45-degree field of view, NIDEK AFC-230, 848x848px: 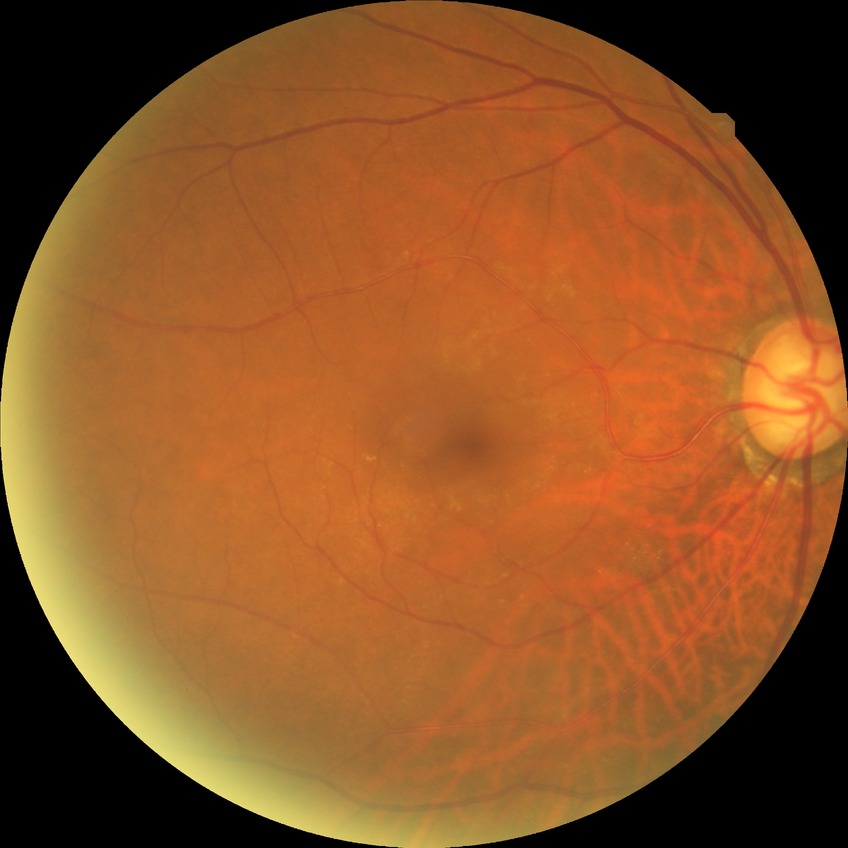
diabetic retinopathy (DR) = NDR (no diabetic retinopathy).